45-degree field of view, 848x848: 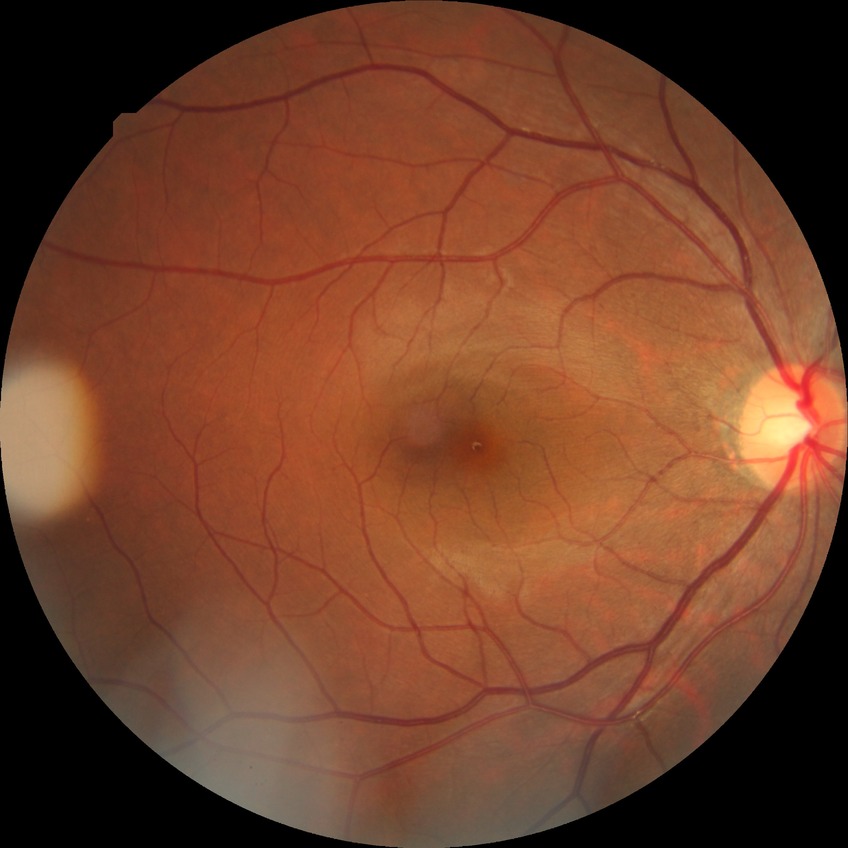

diabetic retinopathy (DR) = NDR (no diabetic retinopathy).